45° field of view, CFP: 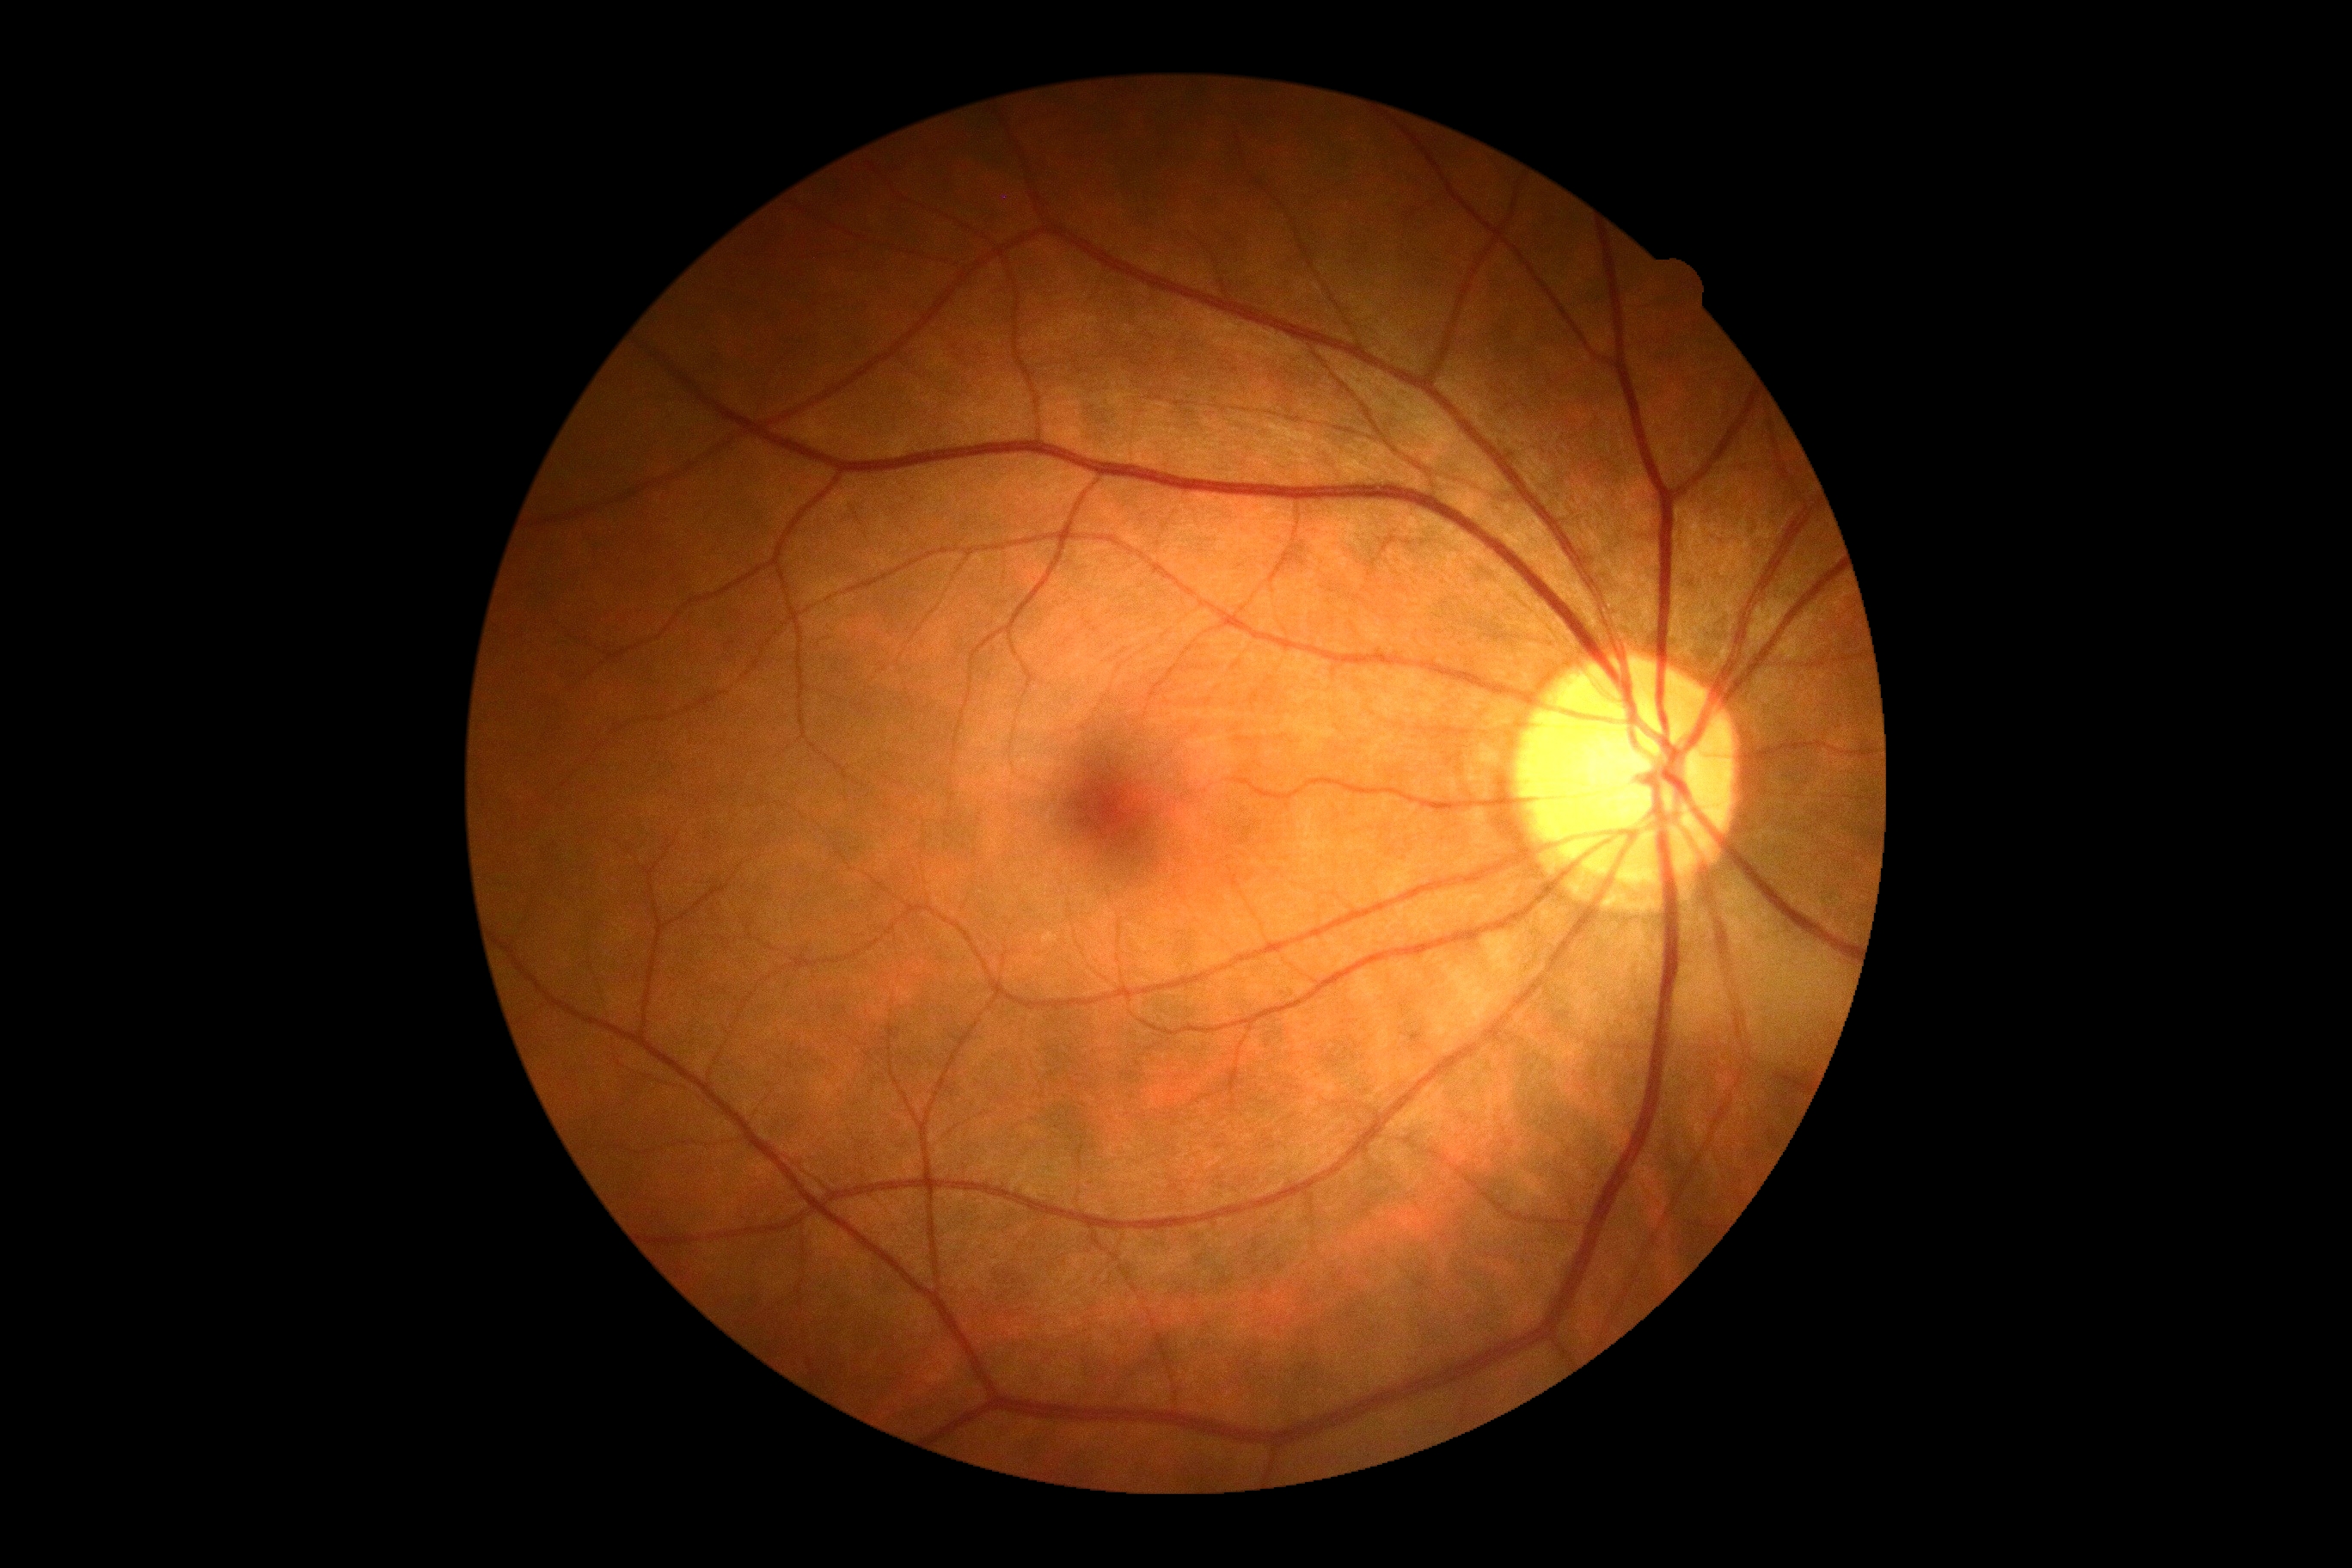
No diabetic retinal disease findings.
DR: grade 0 (no apparent retinopathy).